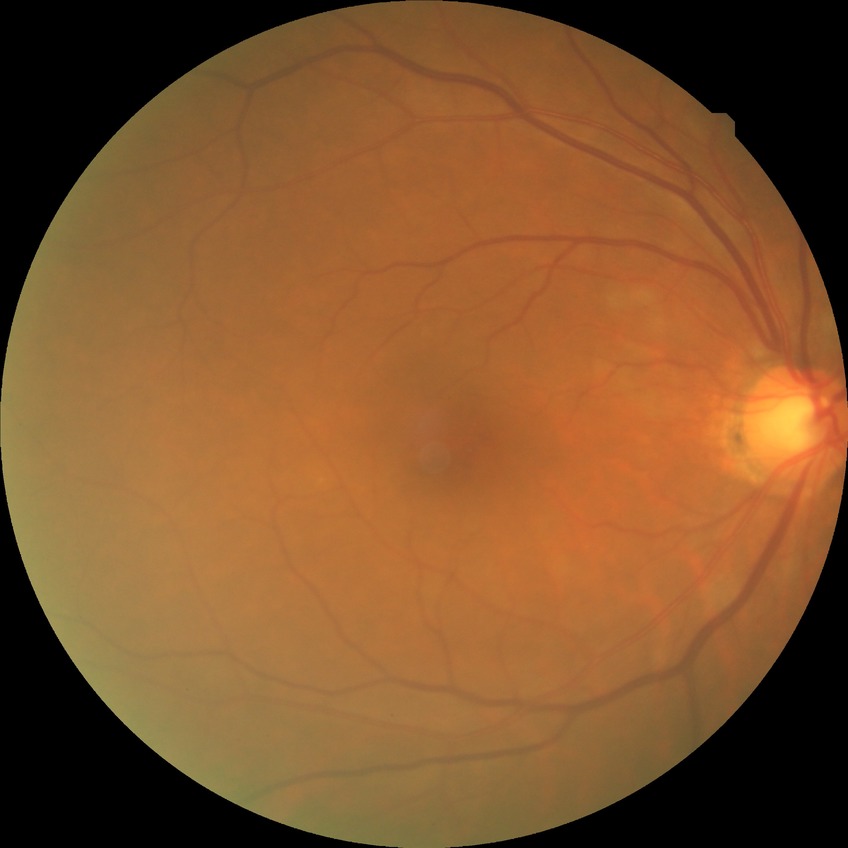 diabetic retinopathy (DR): NDR (no diabetic retinopathy)